2352 by 1568 pixels, color fundus photograph:
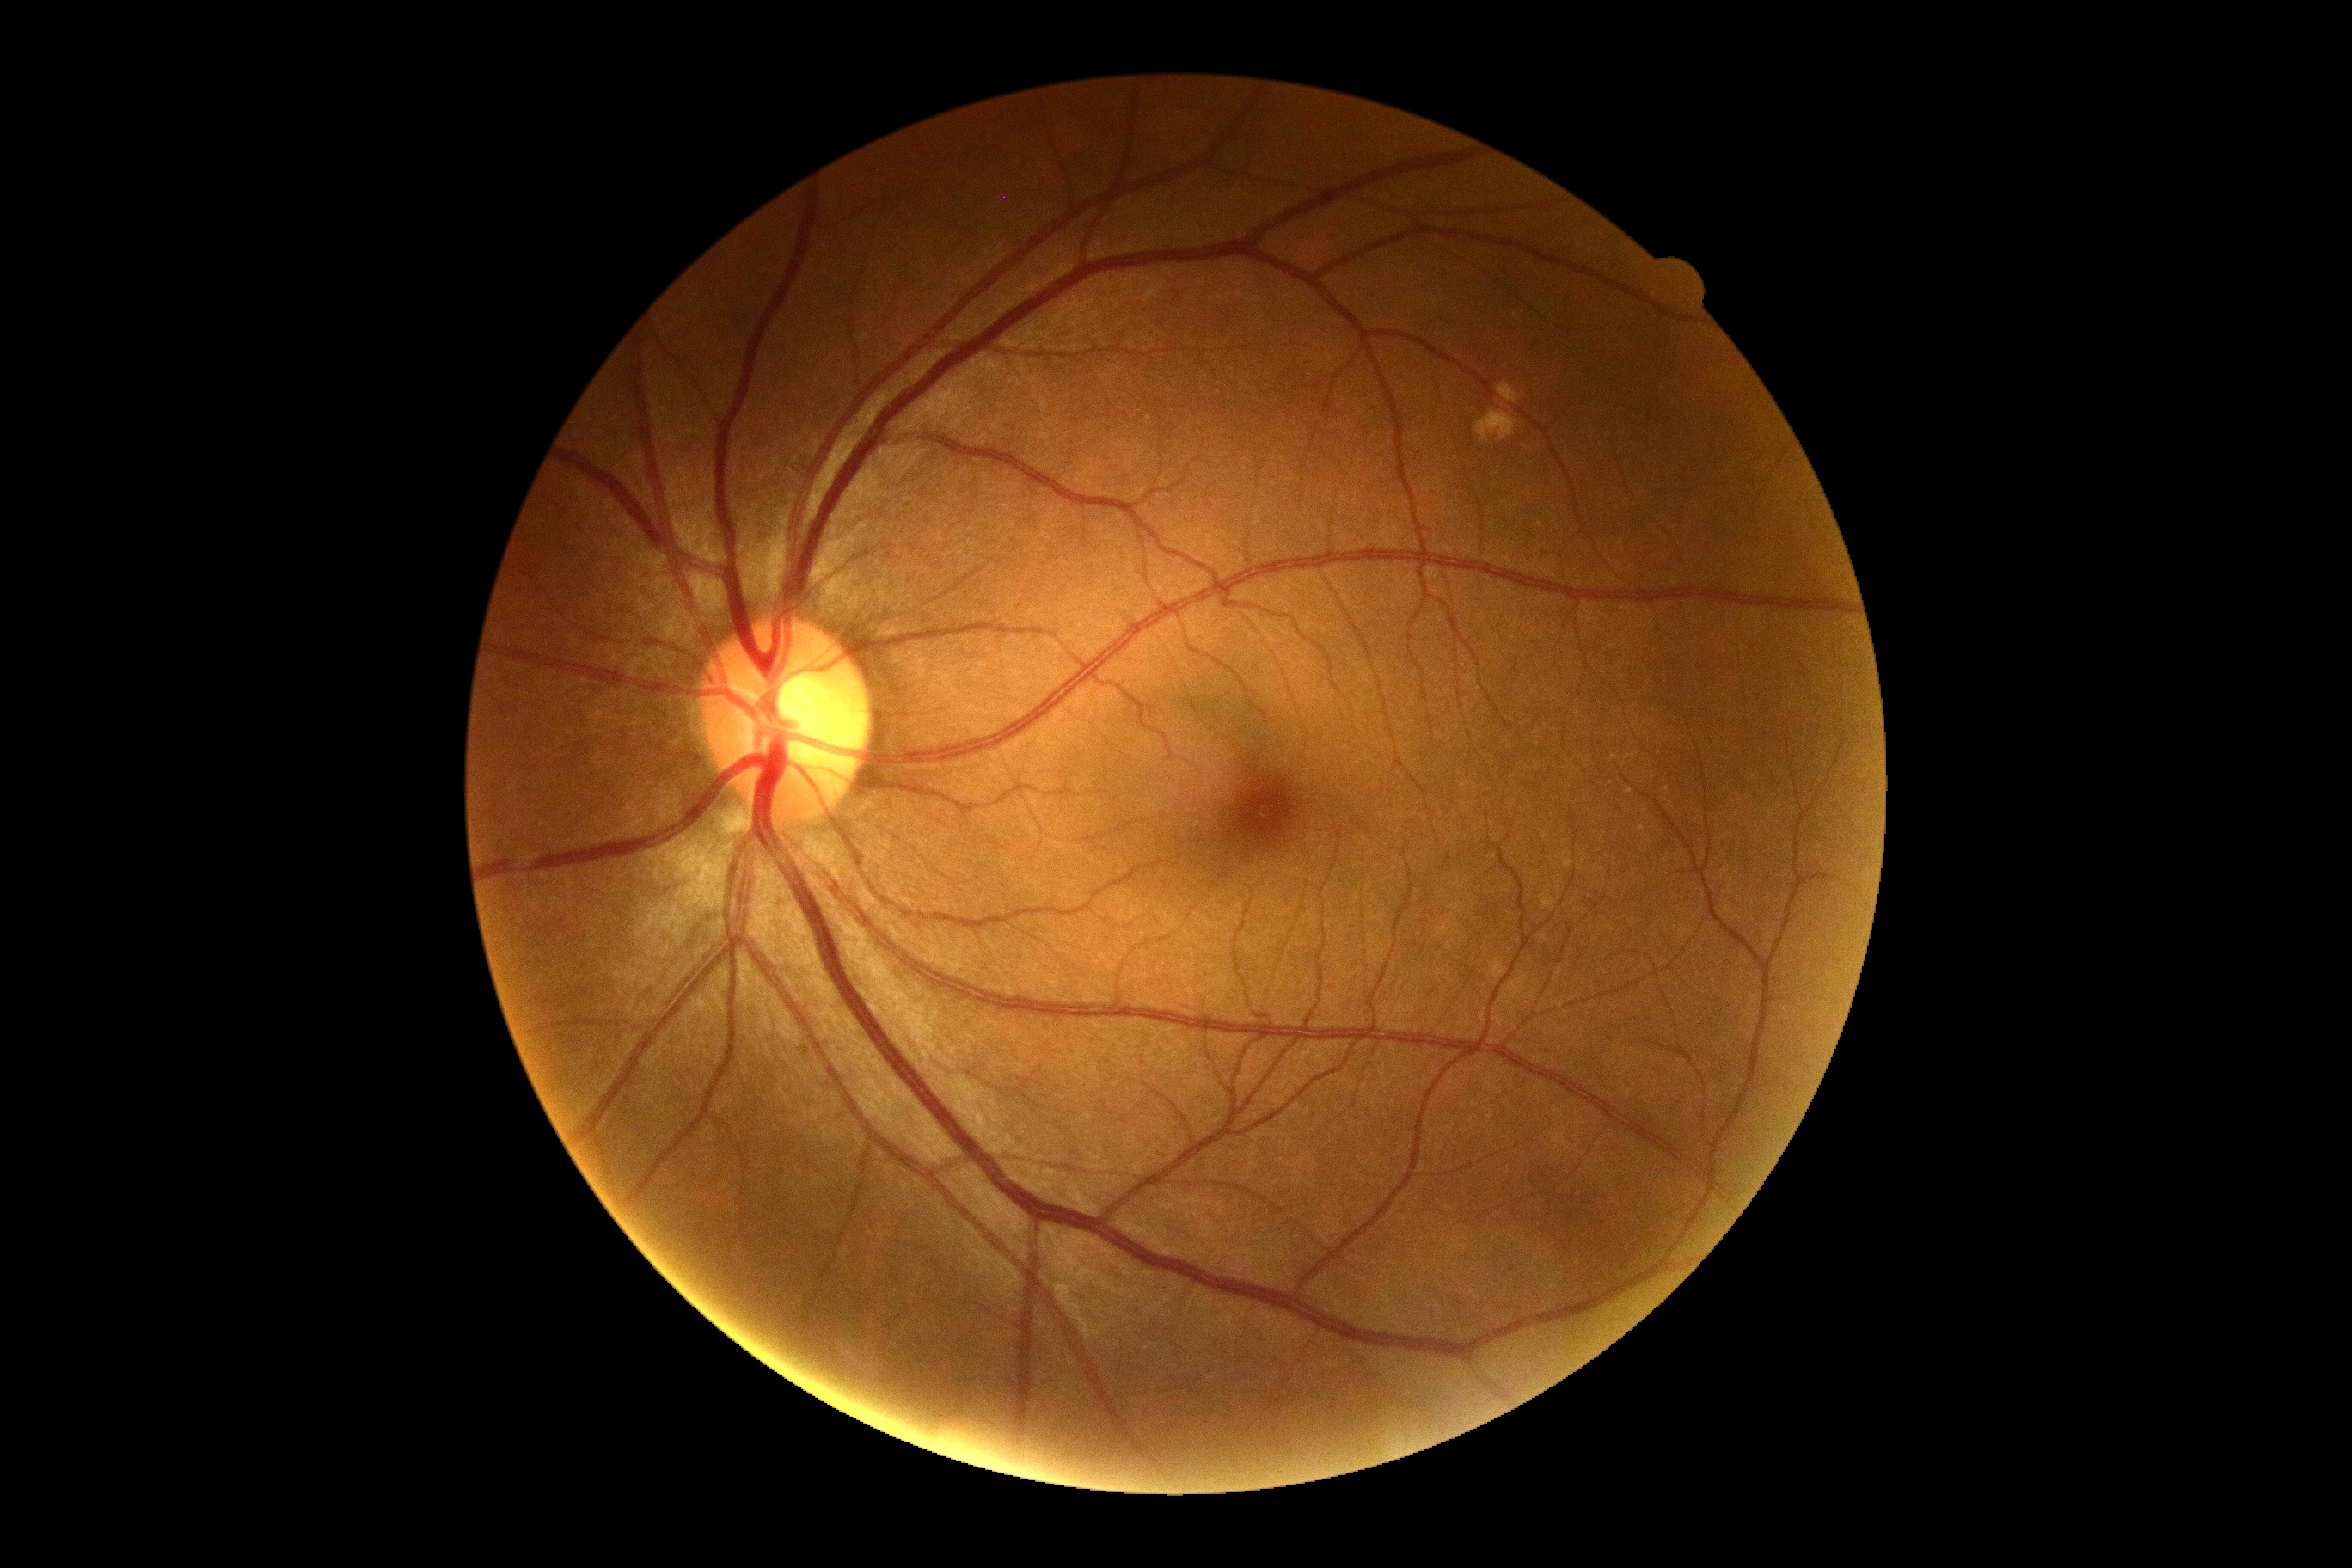
Annotations:
– diabetic retinopathy grade: 0